Pediatric wide-field fundus photograph. Image size 640x480. Acquired on the Clarity RetCam 3: 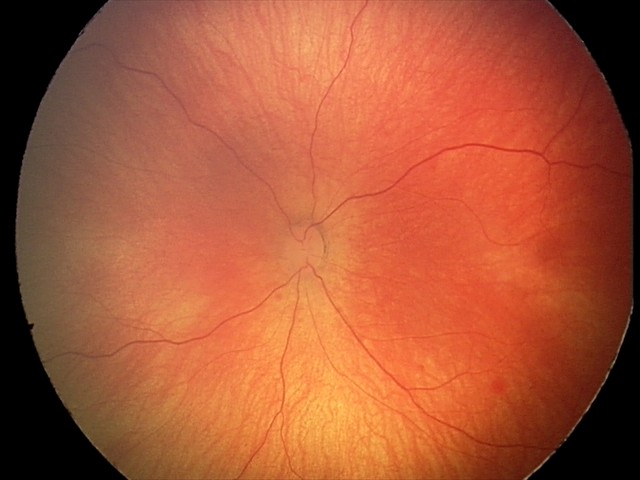

Examination diagnosed as retinal hemorrhages.